Color fundus image.
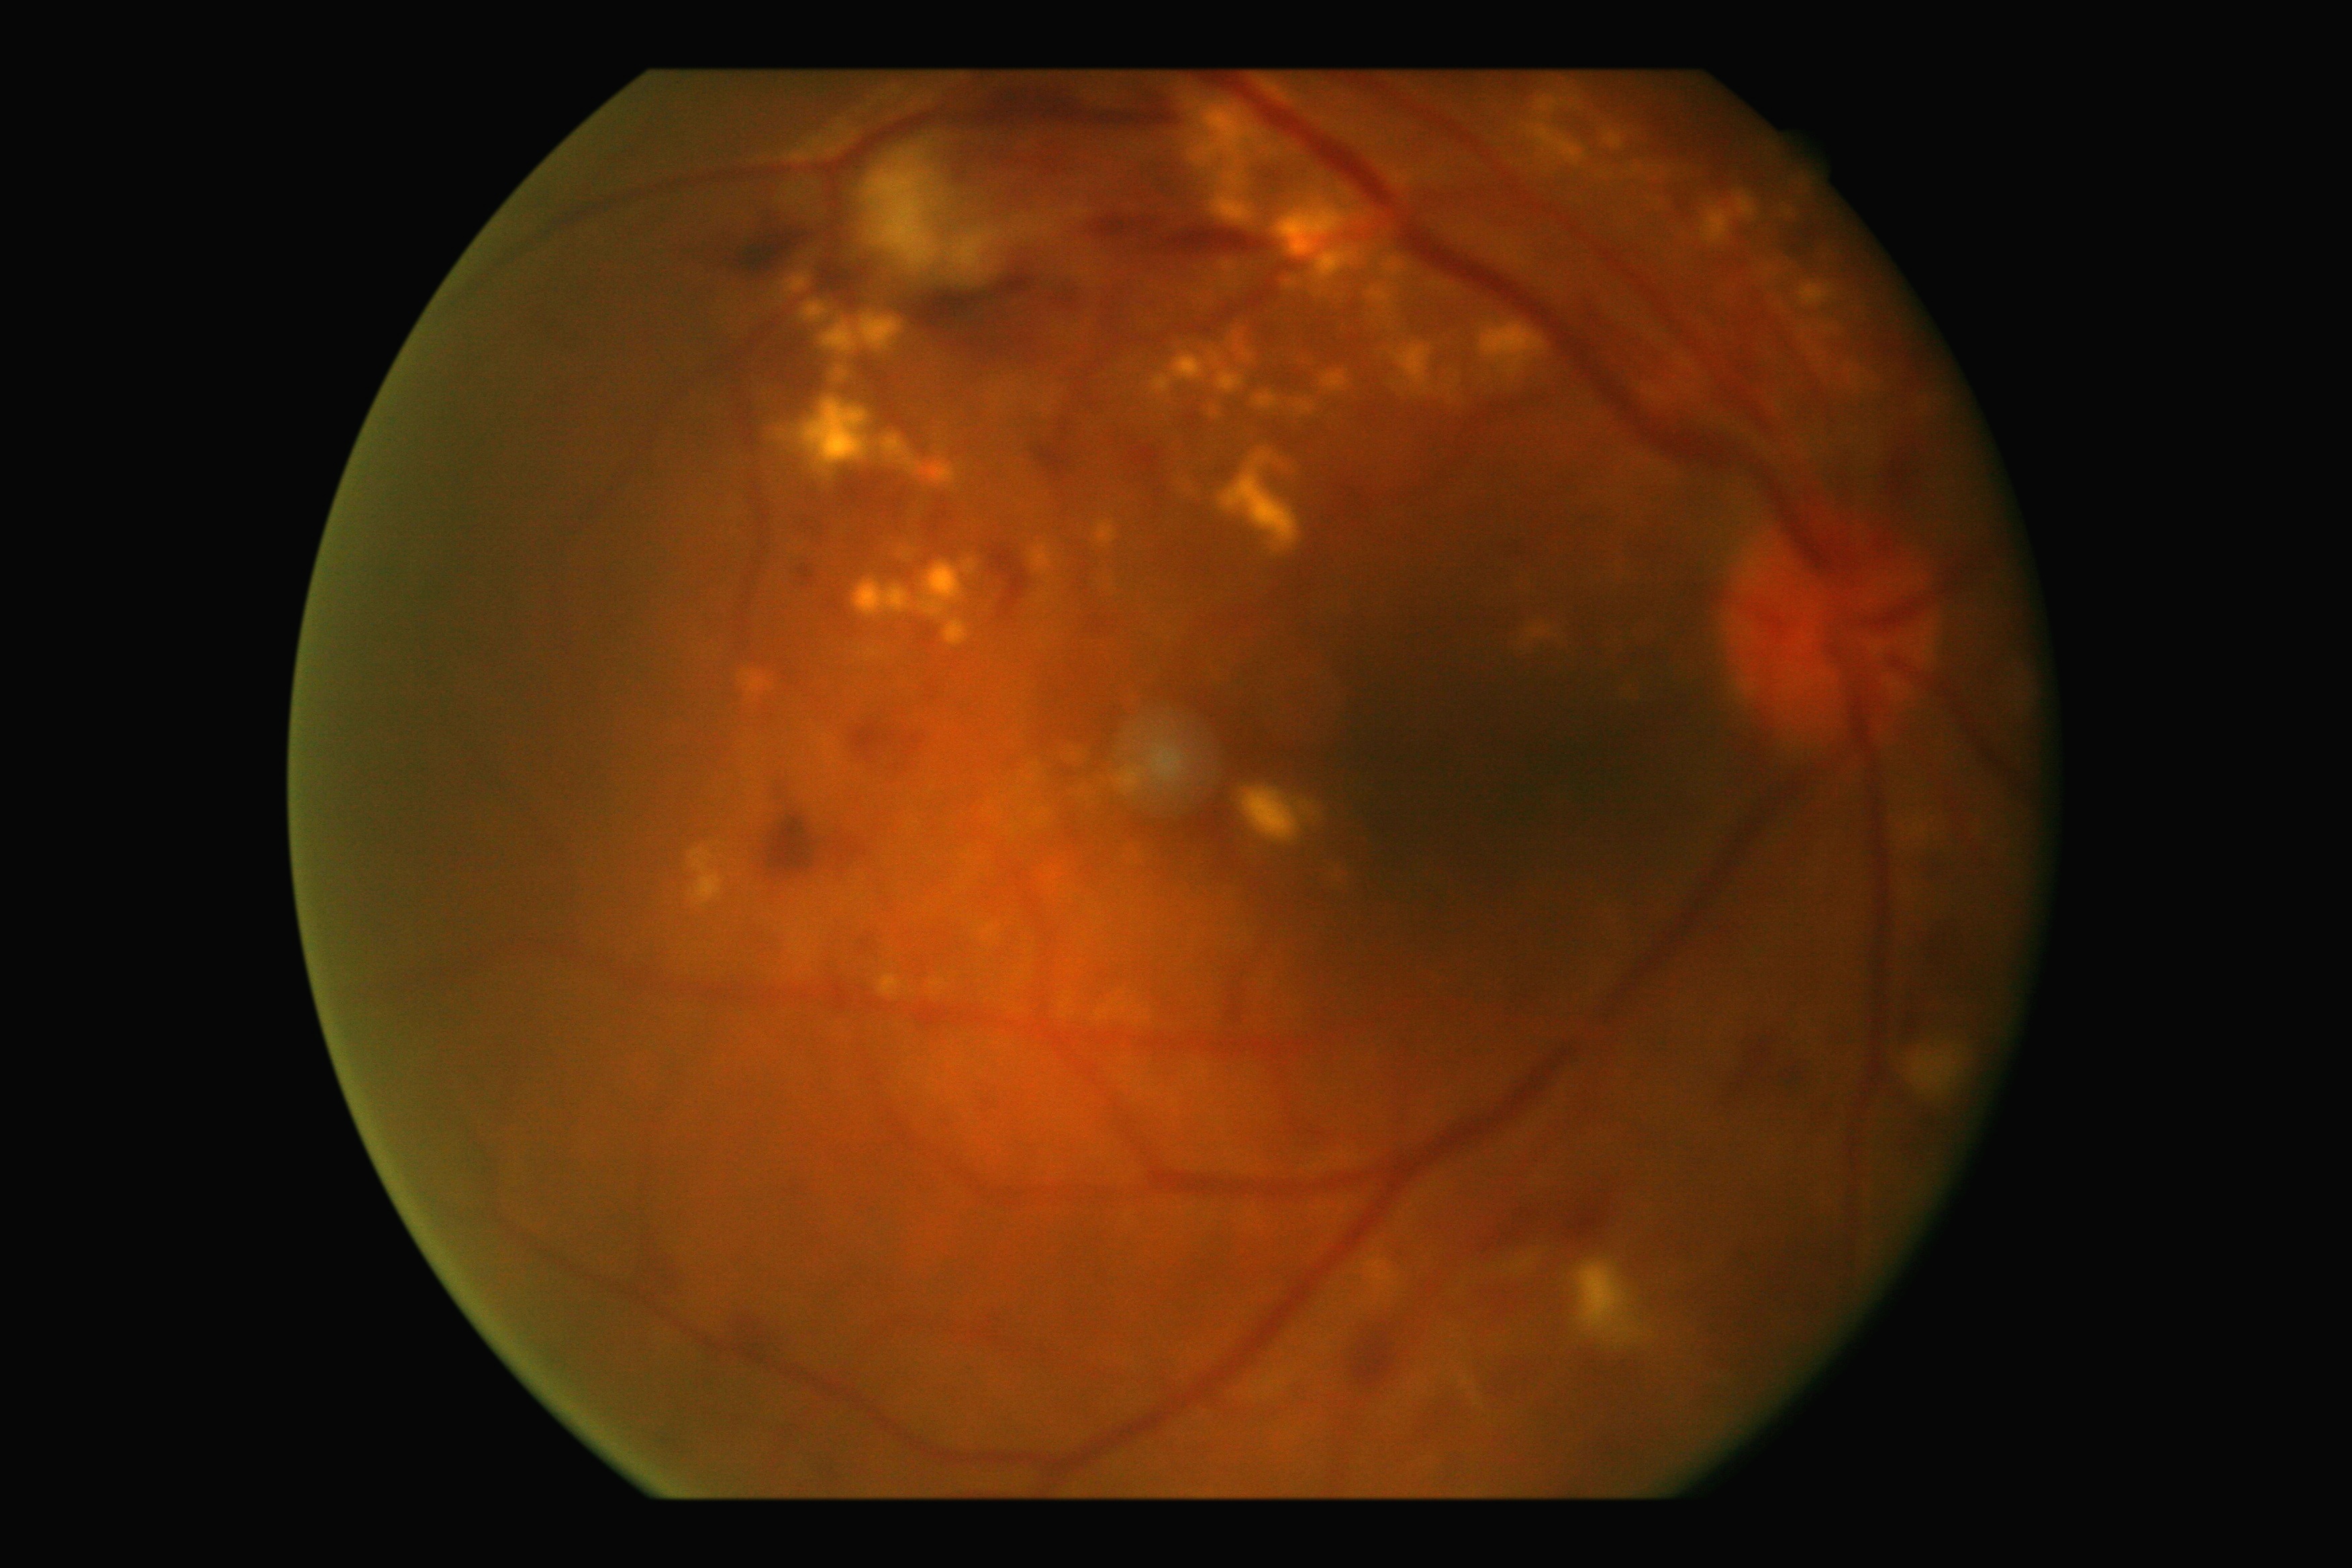 Disease class: non-proliferative diabetic retinopathy. Diabetic retinopathy grade: 2/4.